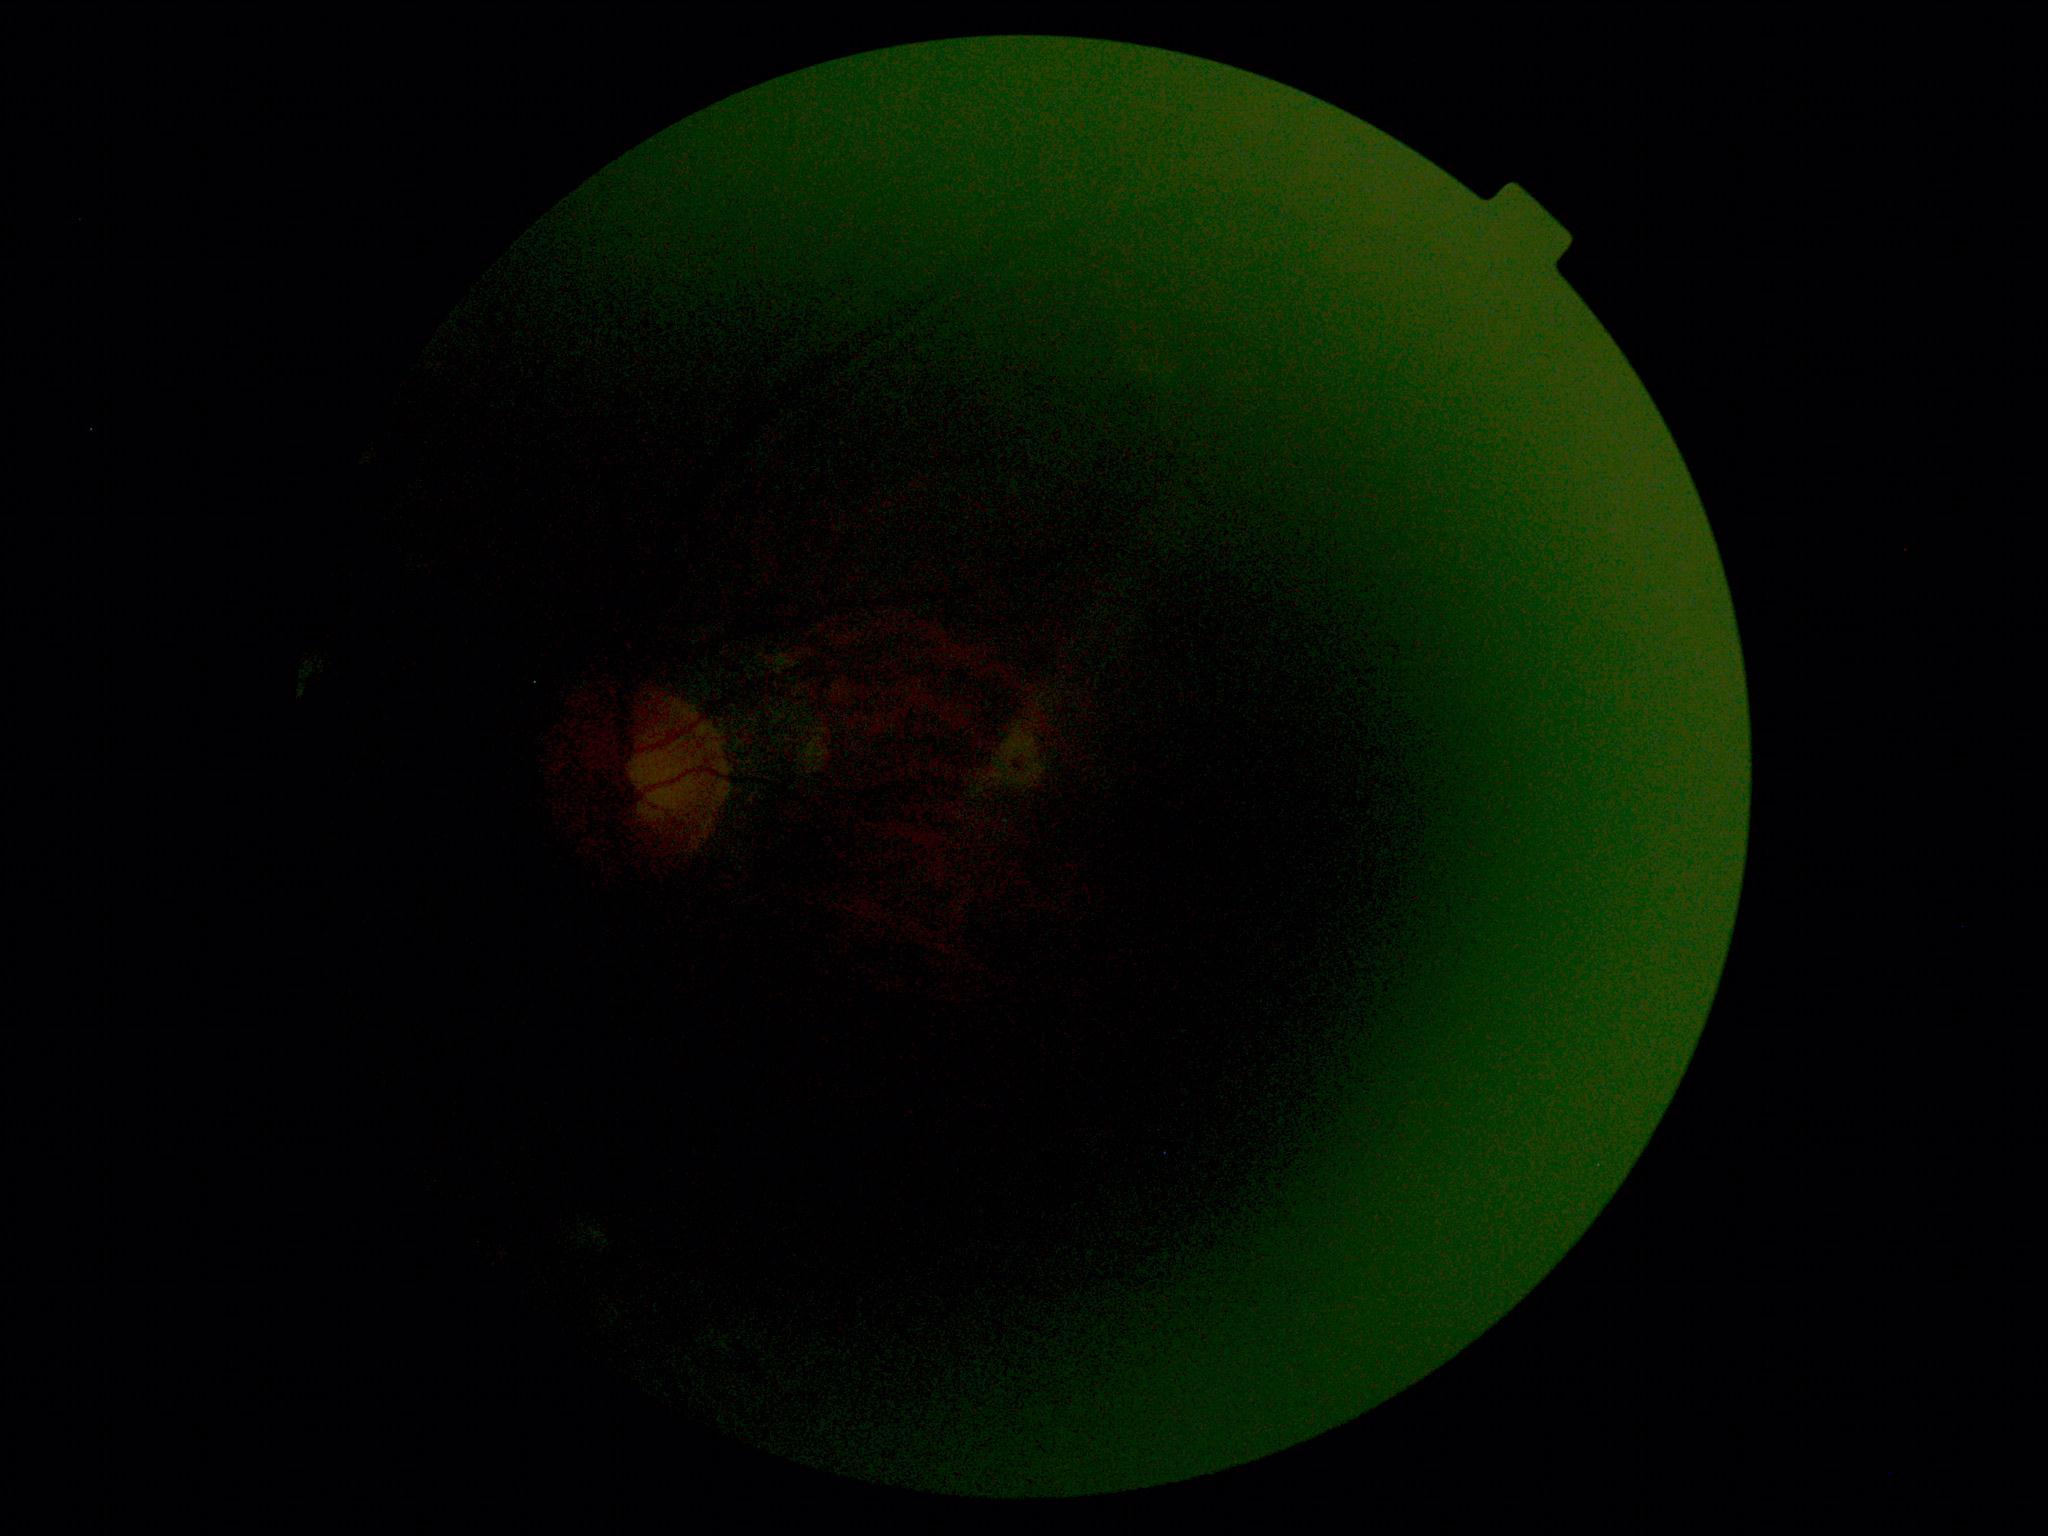

Diabetic retinopathy (DR): ungradable due to poor image quality.